Pediatric retinal photograph (wide-field): 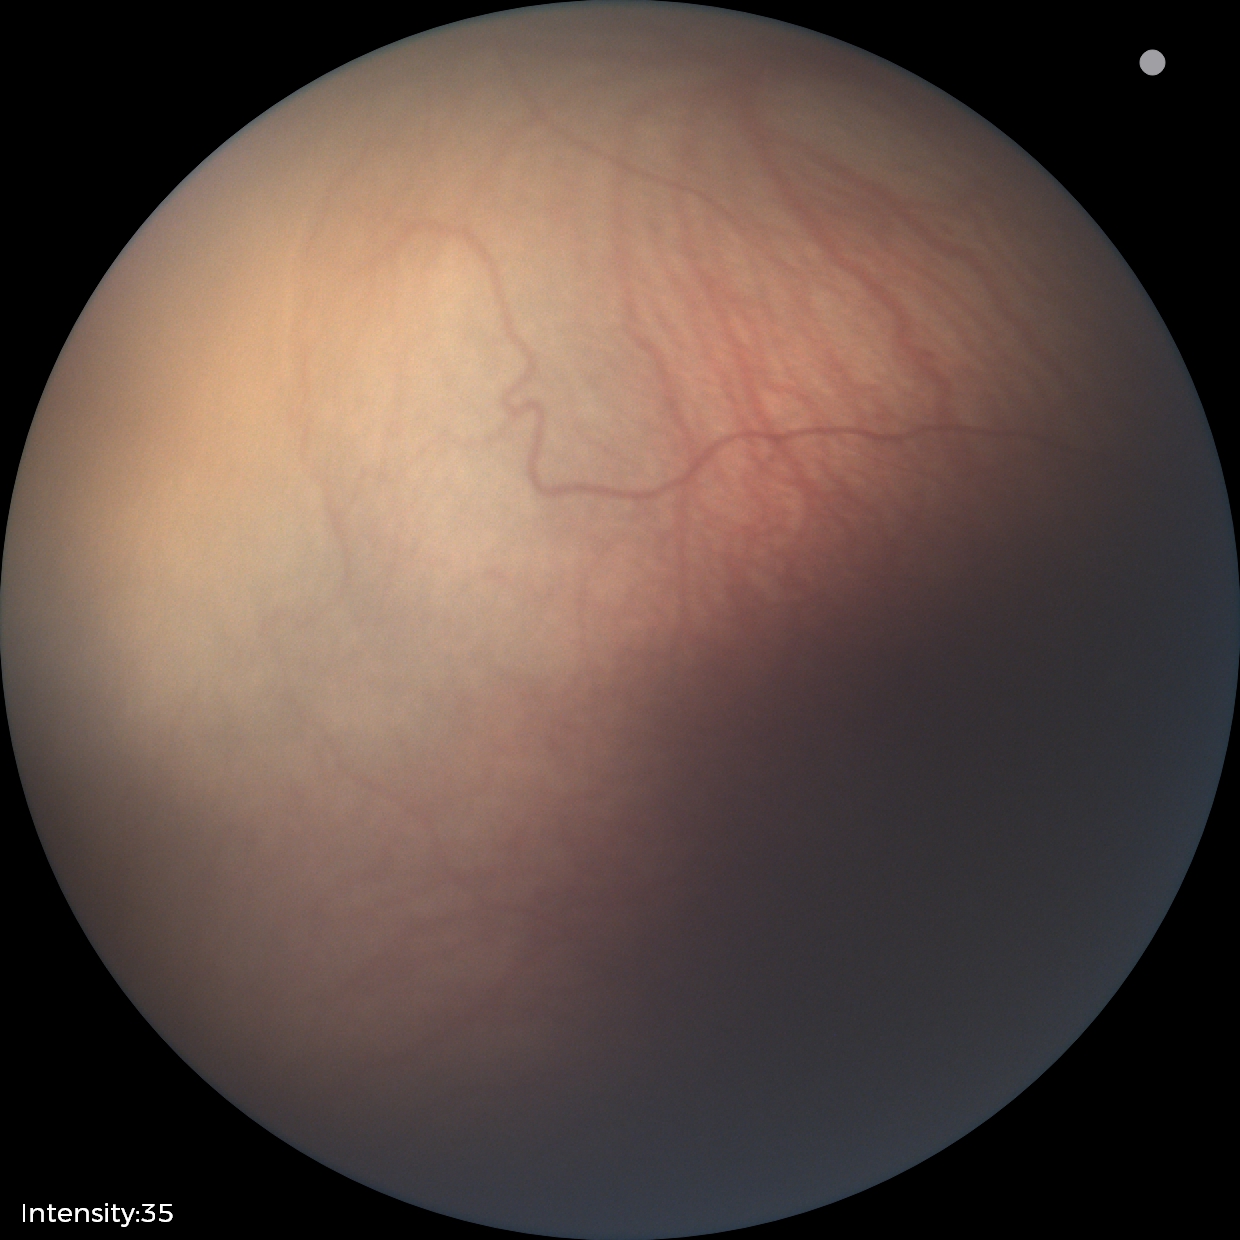 Plus disease: absent; retinopathy of prematurity stage: 1.